Wide-field fundus image from infant ROP screening; camera: Clarity RetCam 3 (130° FOV): 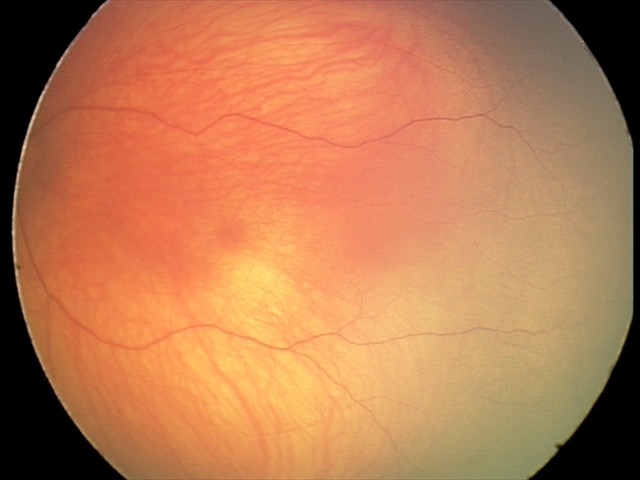
Screening diagnosis: physiological retinal finding.